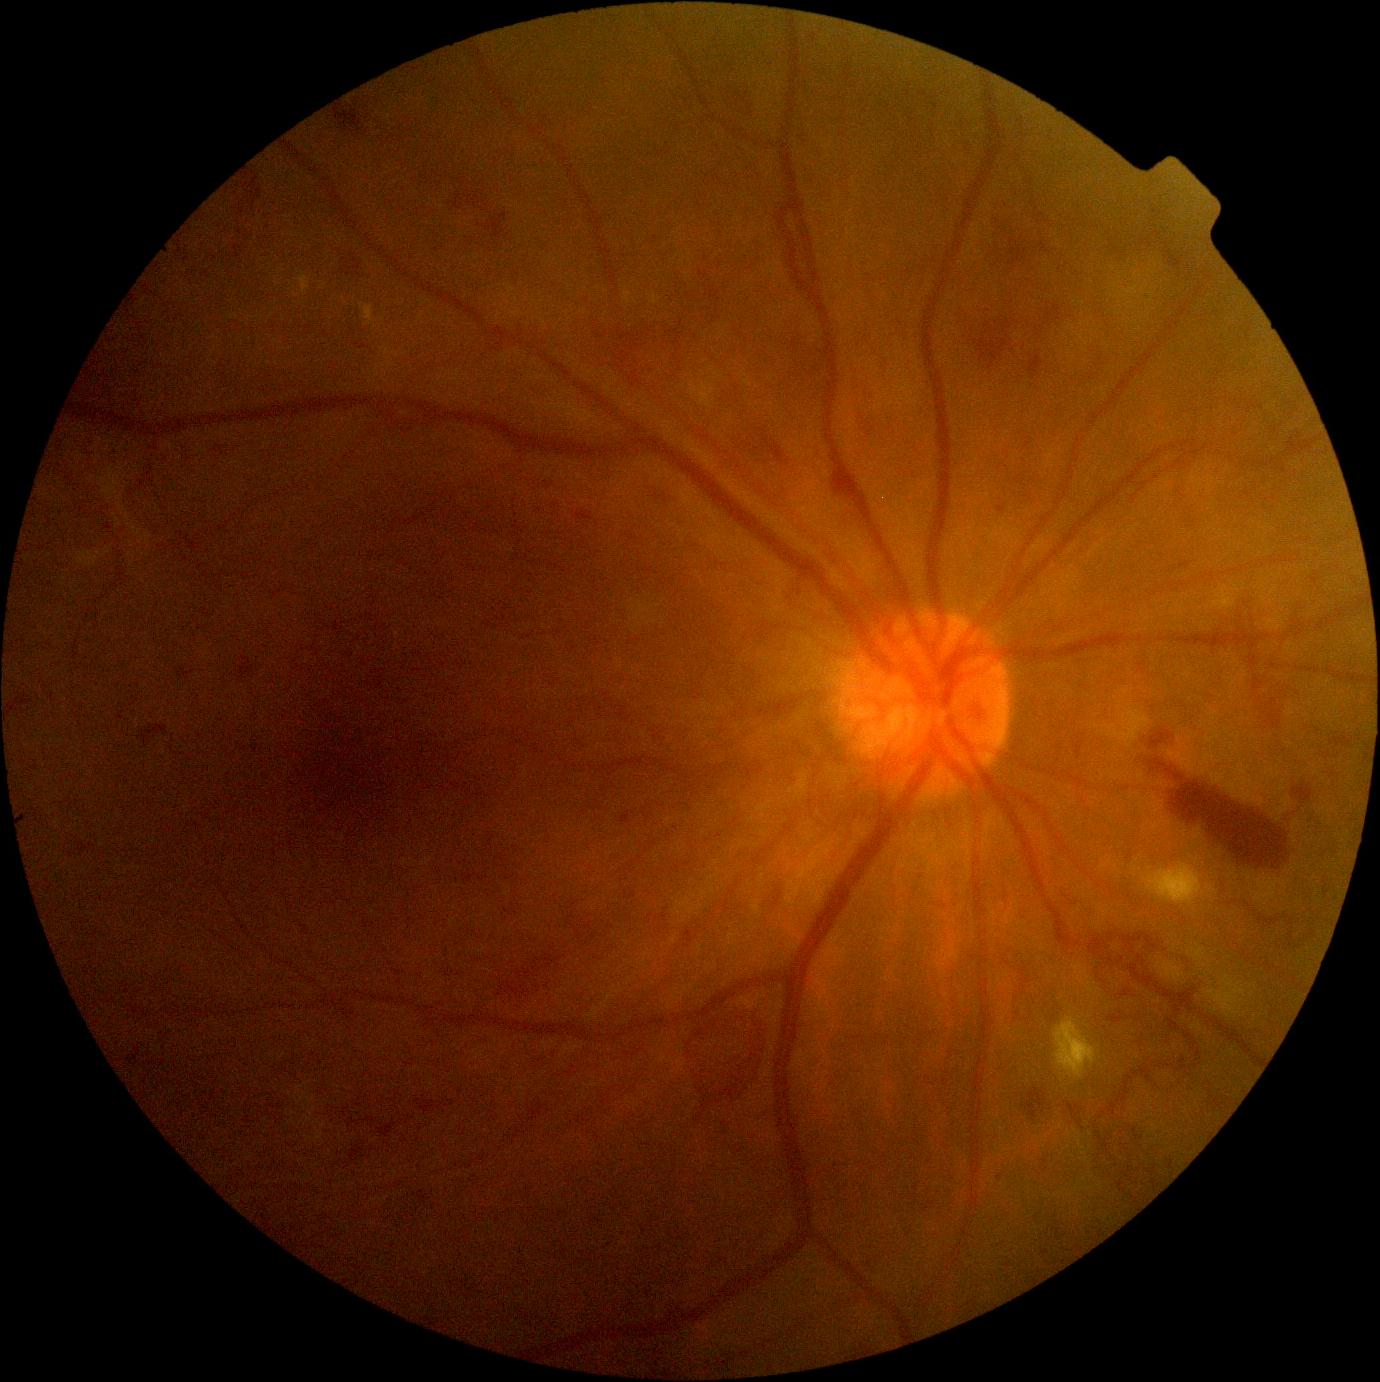

Retinopathy grade is severe NPDR (3).